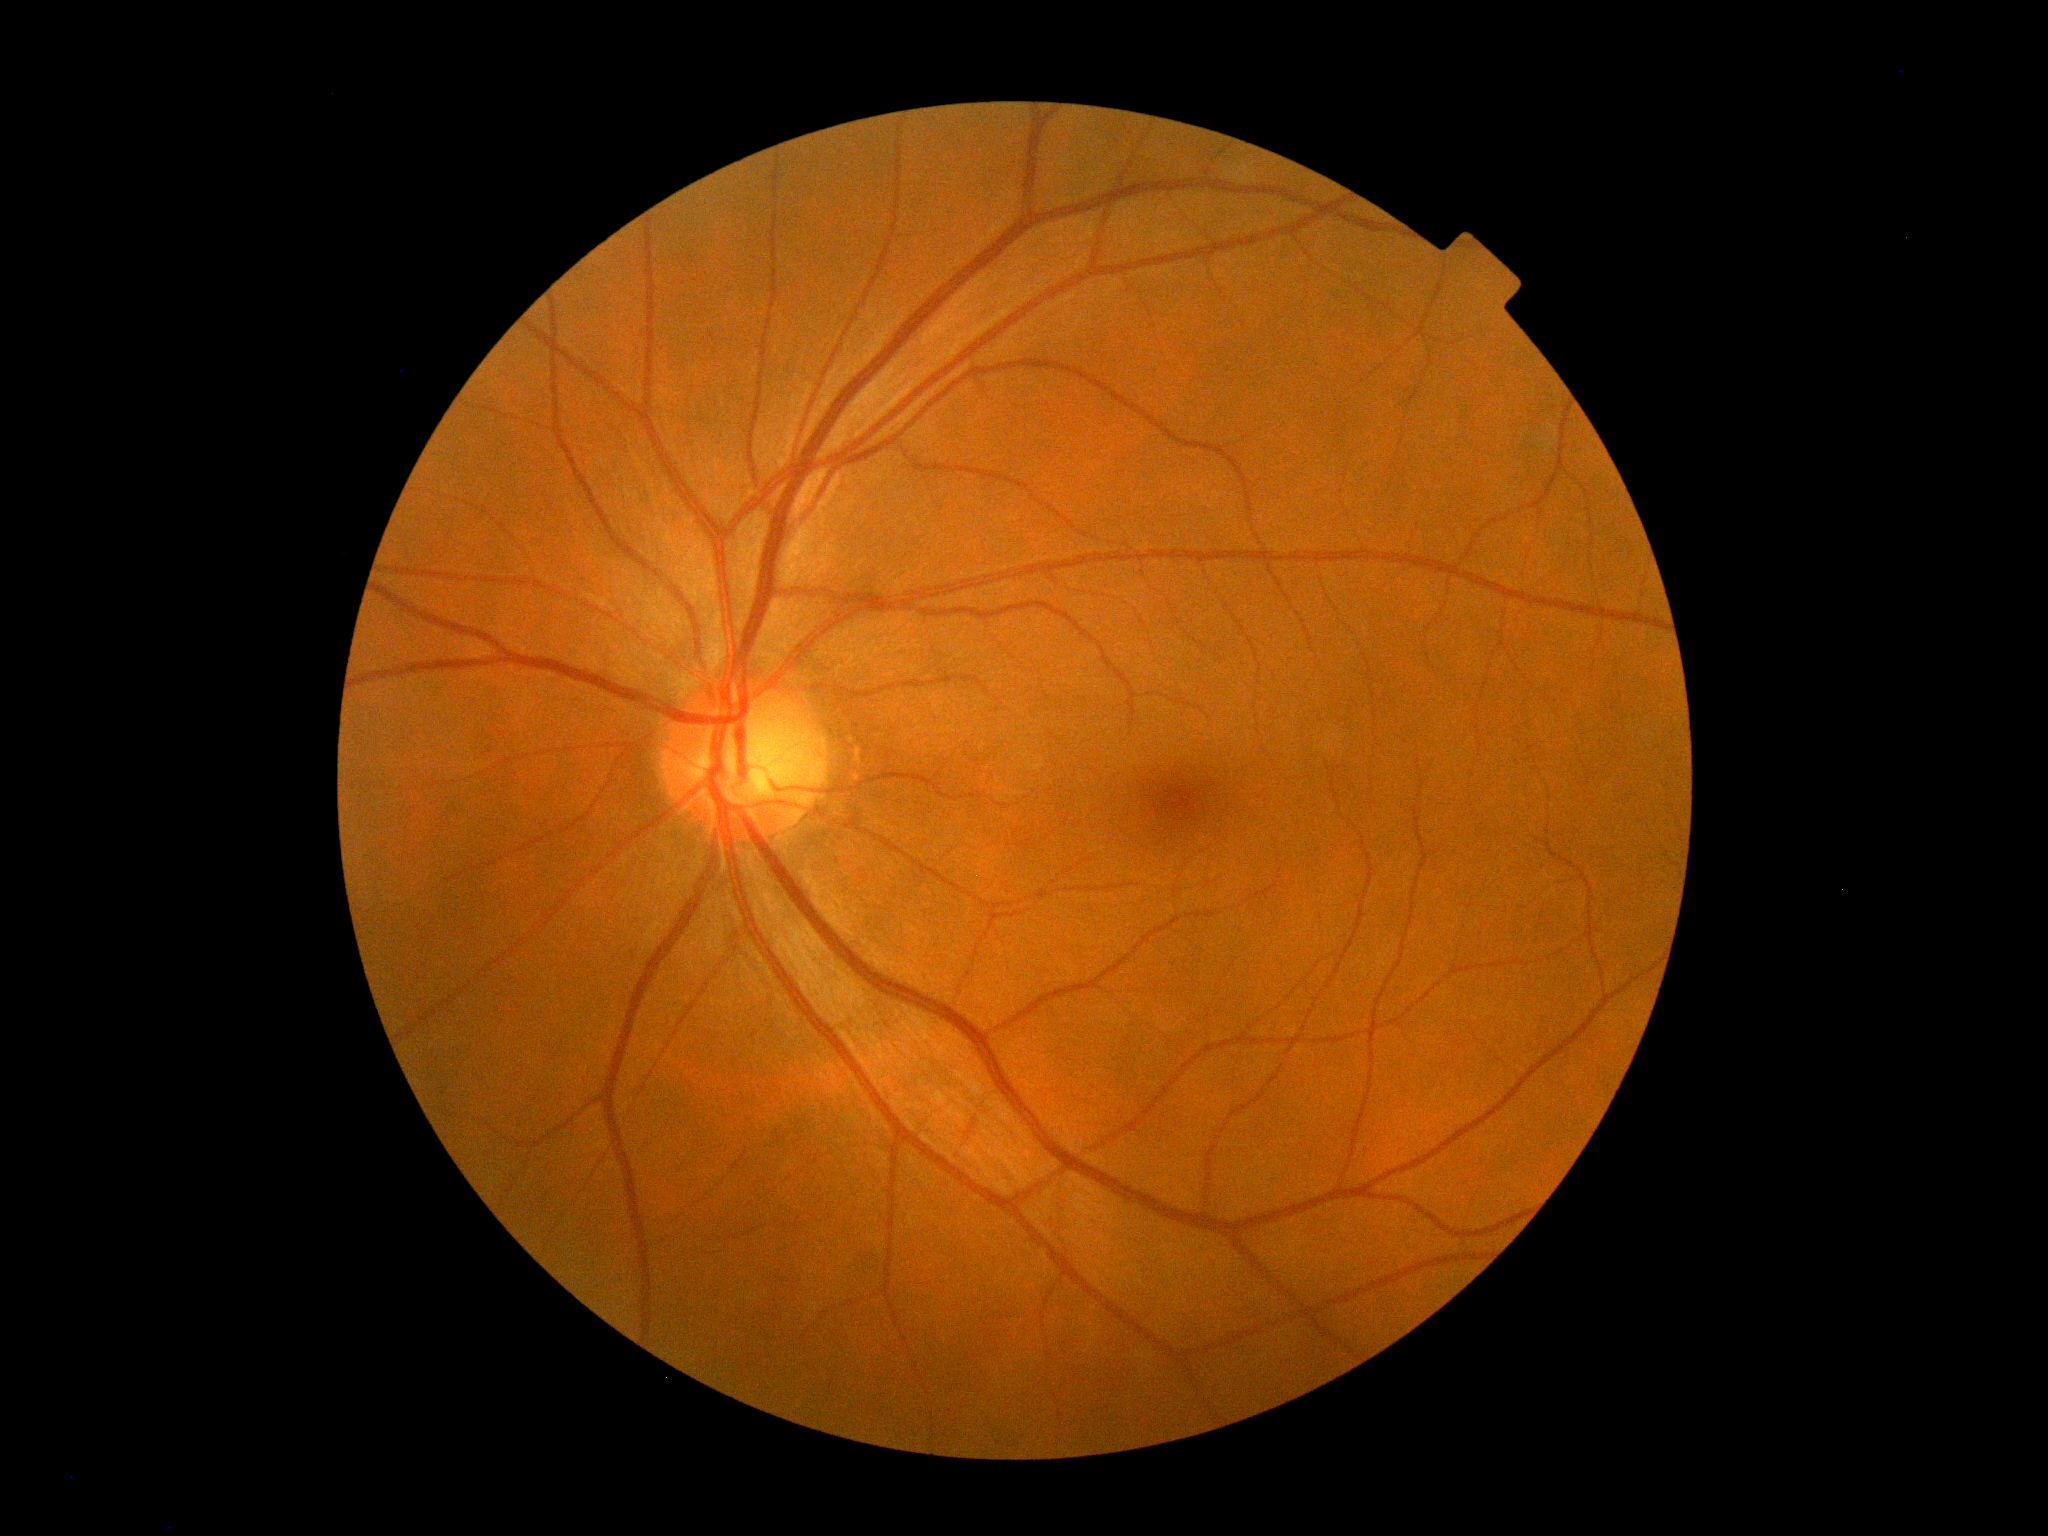
DR stage=grade 0 (no apparent retinopathy) — no visible signs of diabetic retinopathy.